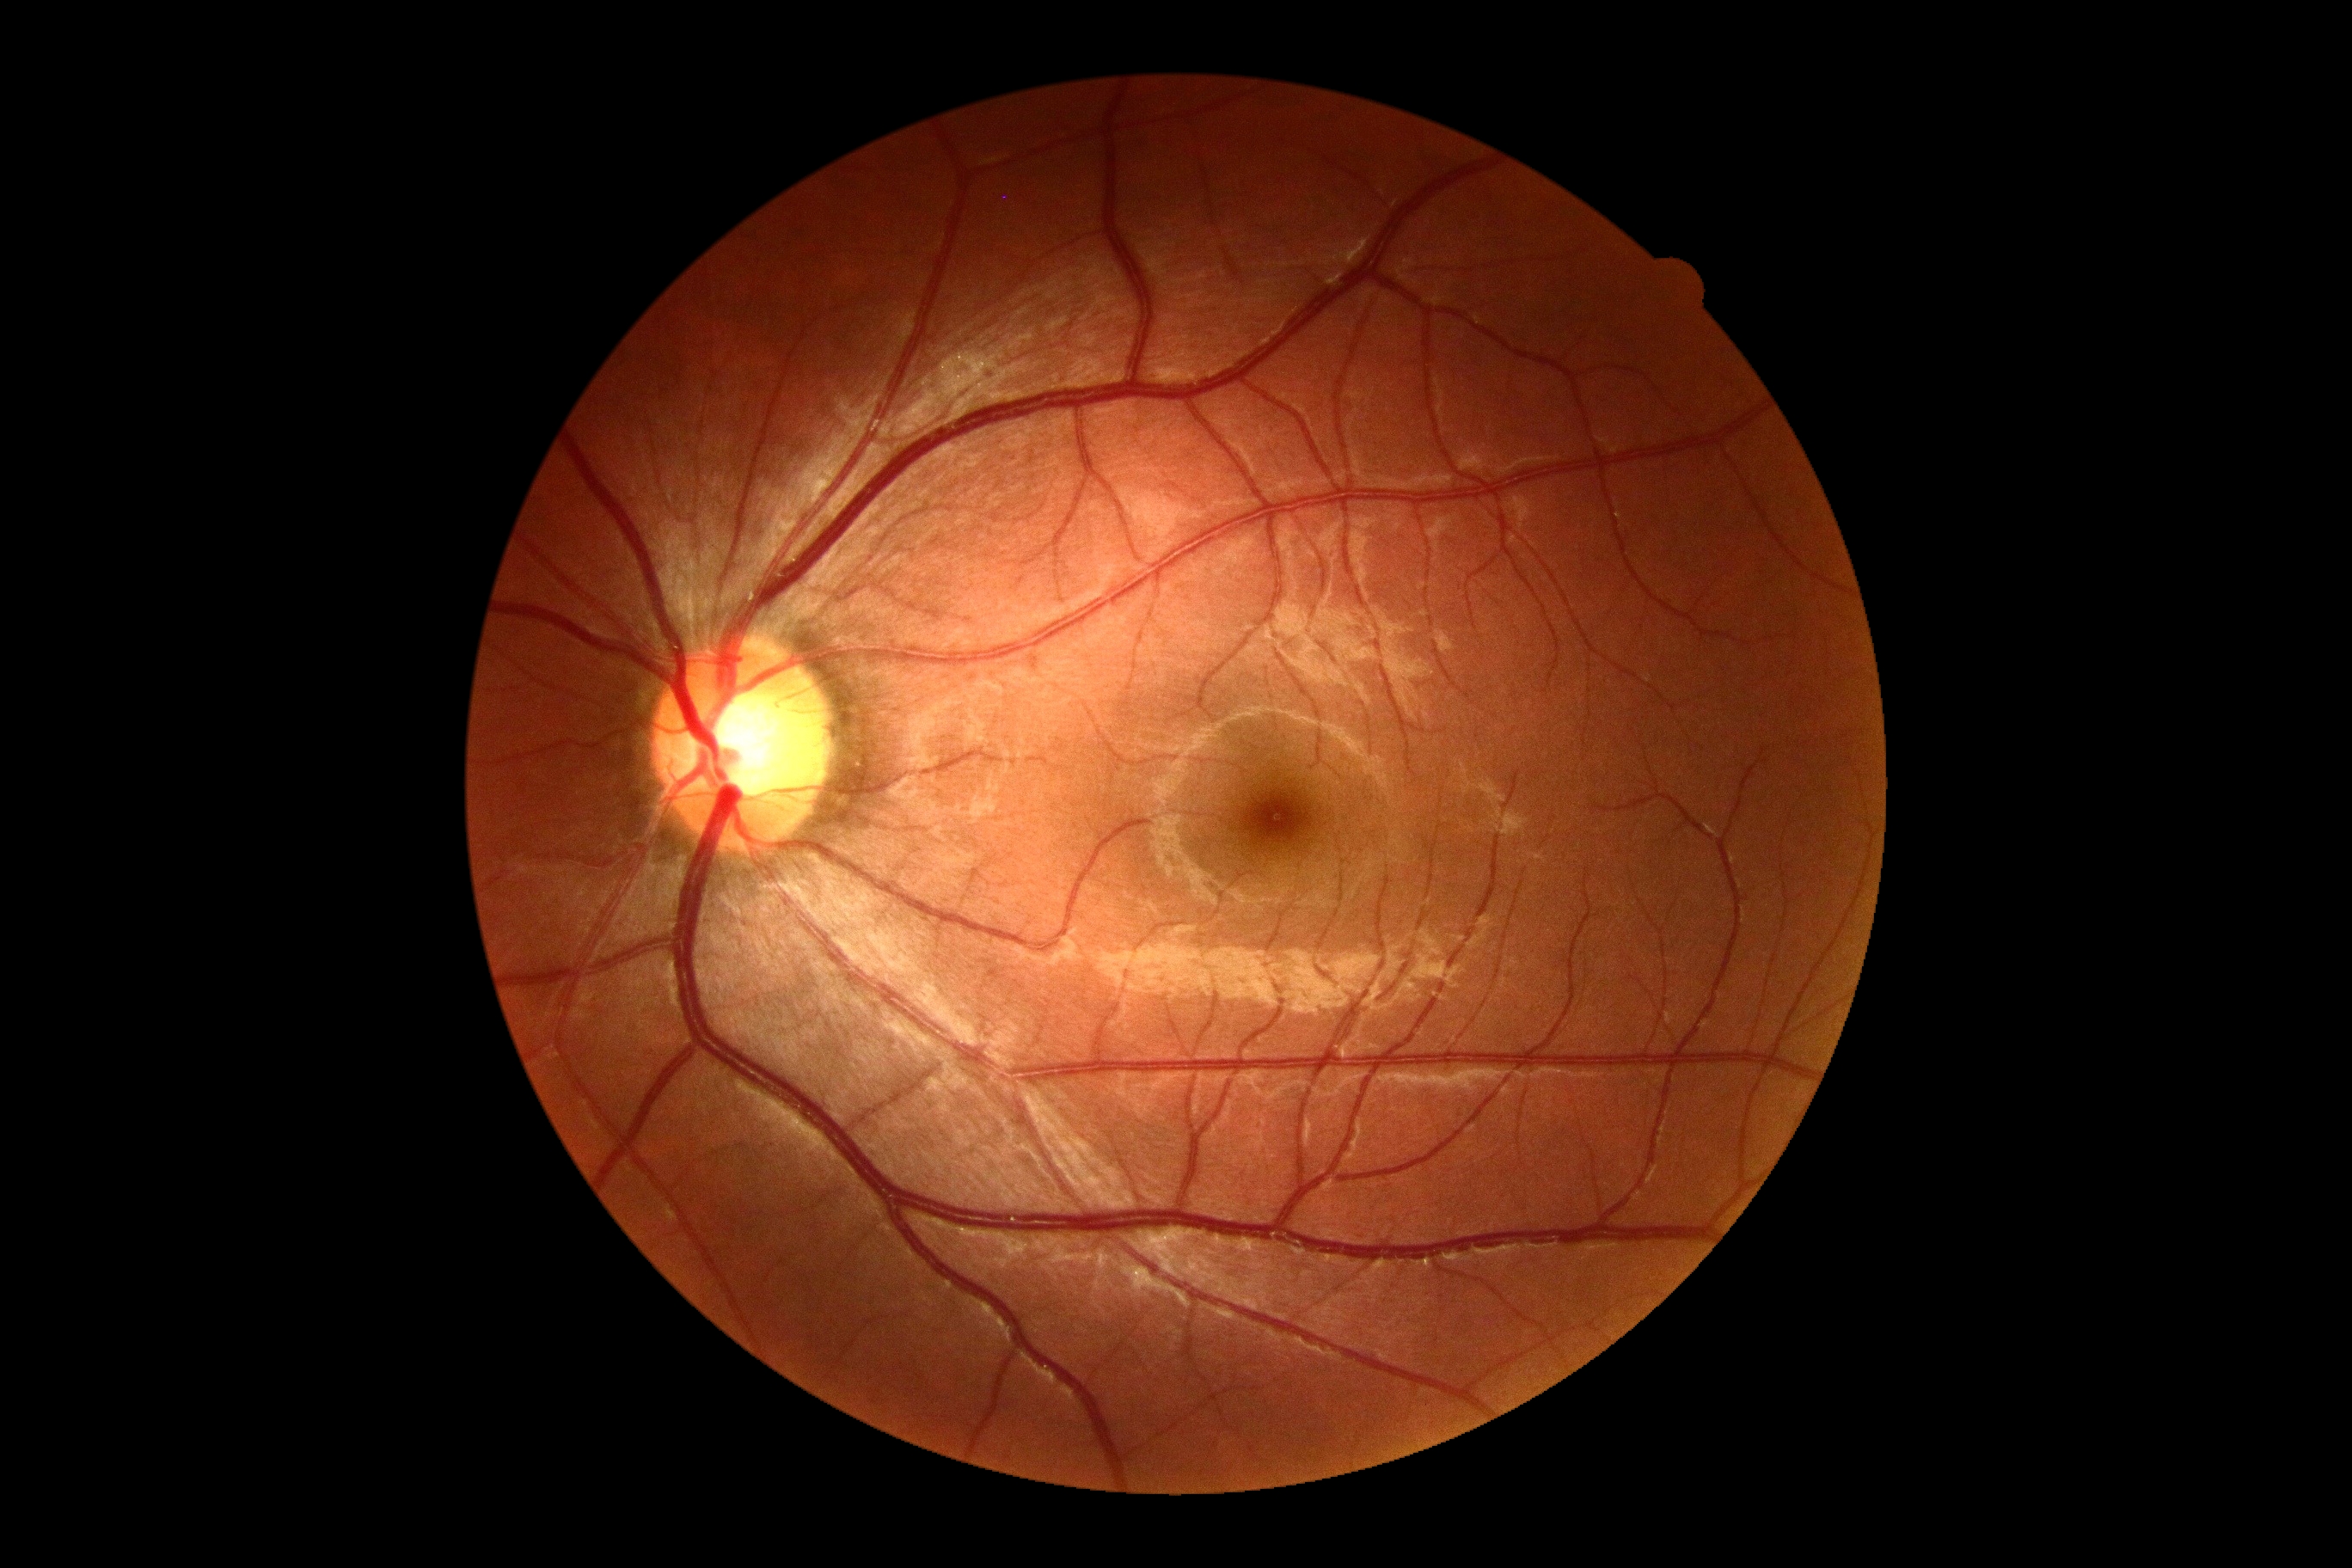
Retinopathy: no apparent retinopathy (grade 0).